130° field of view (Clarity RetCam 3). Image size 640x480. Wide-field contact fundus photograph of an infant:
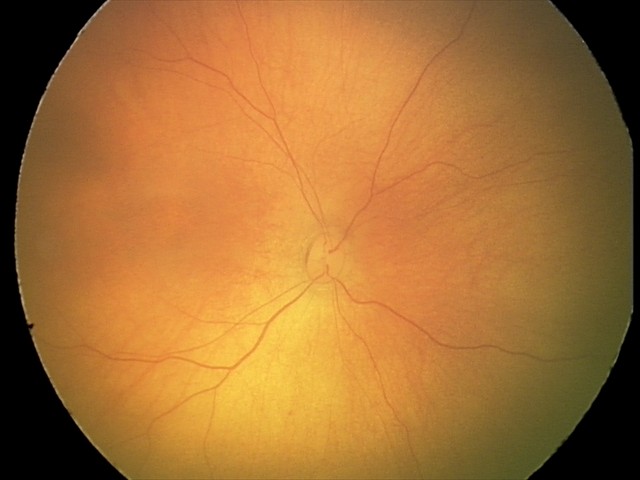
Screening examination with no abnormal retinal findings.